Posterior pole photograph
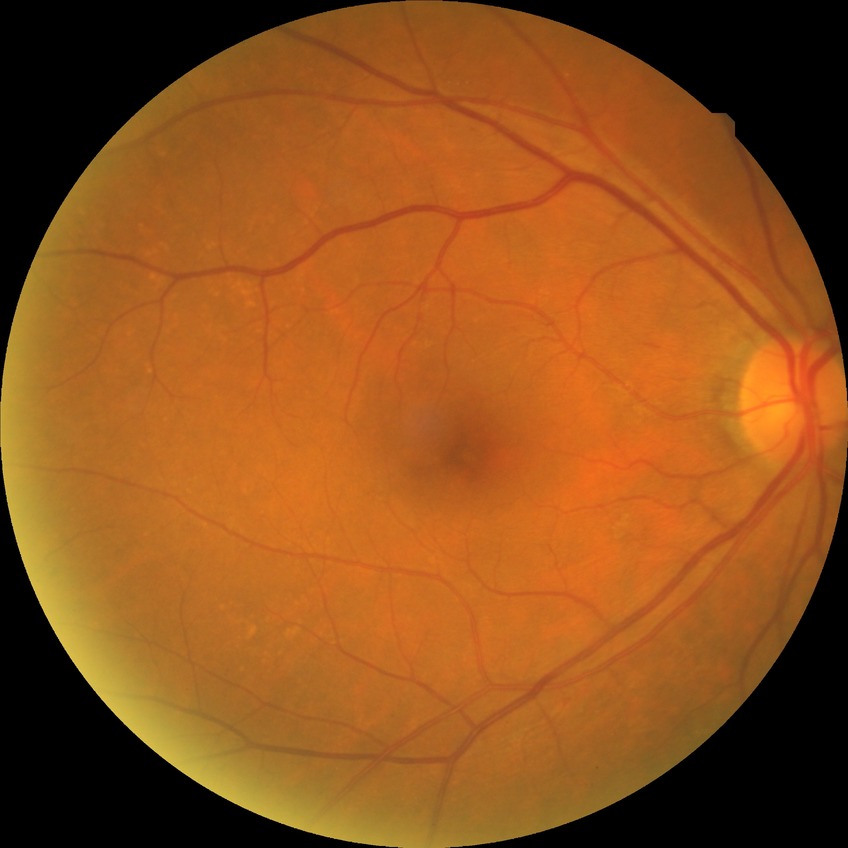
Retinopathy grade: simple diabetic retinopathy.